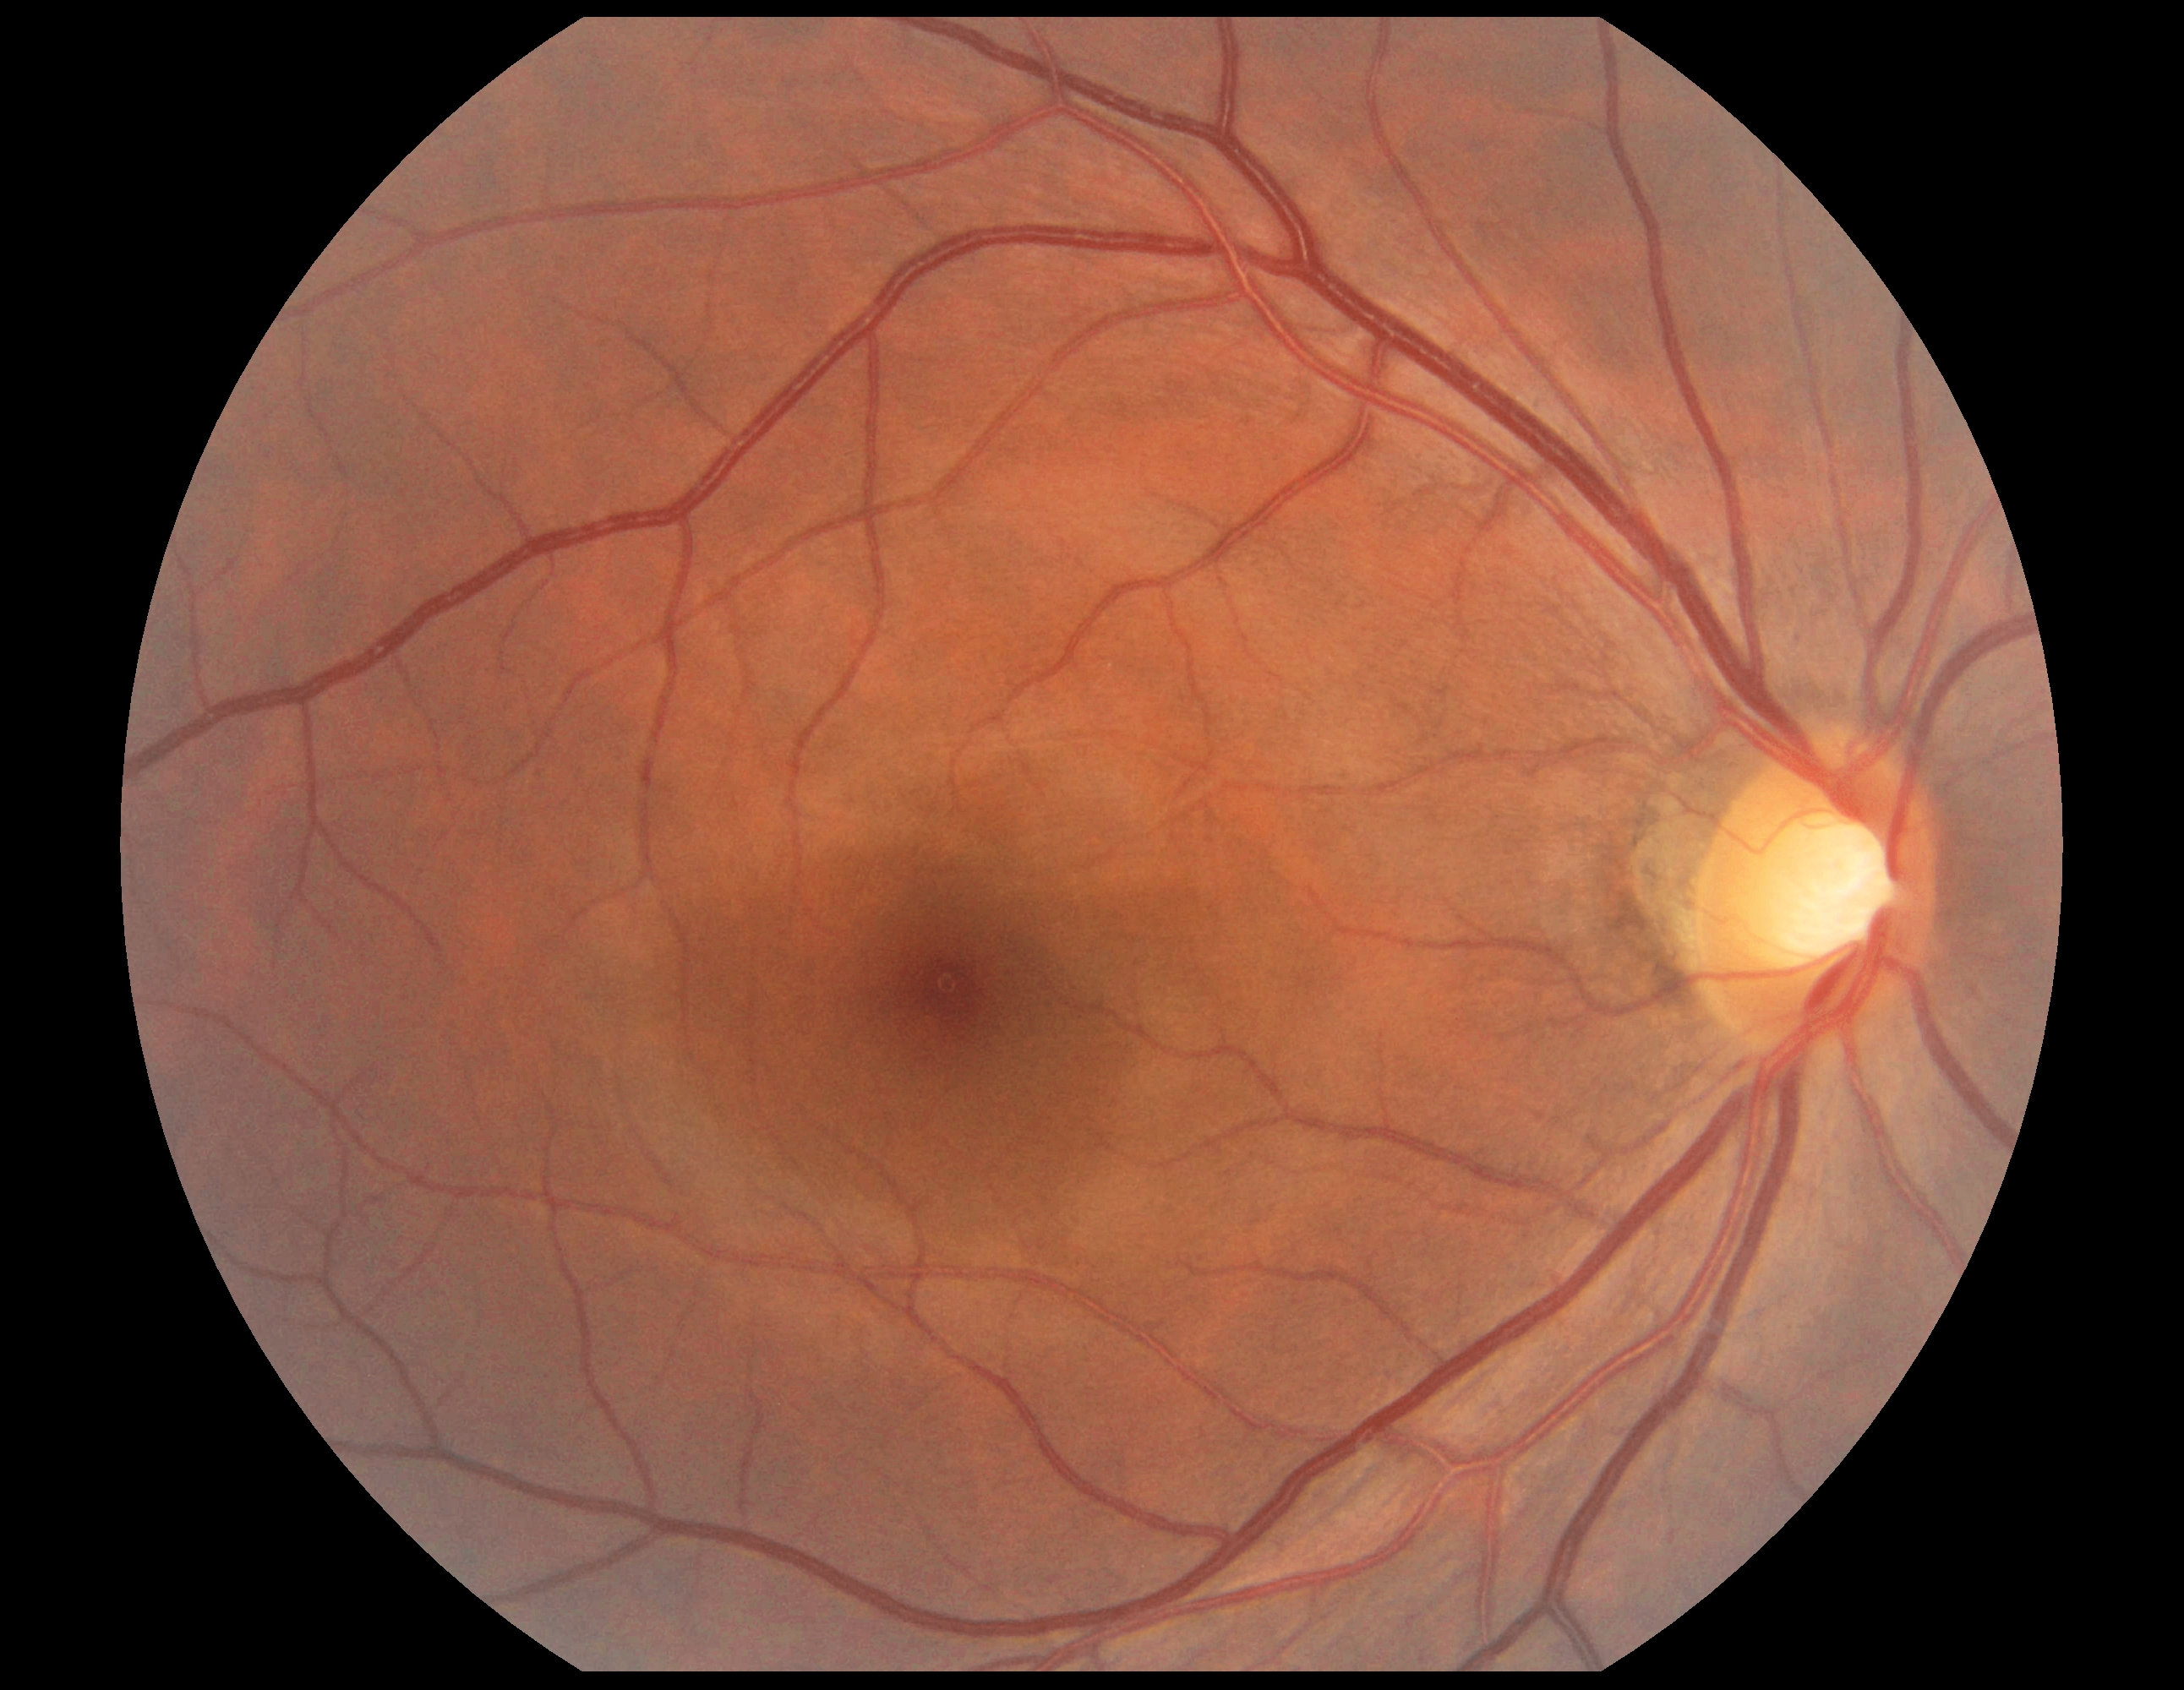

DR grade: 0 (no apparent retinopathy).